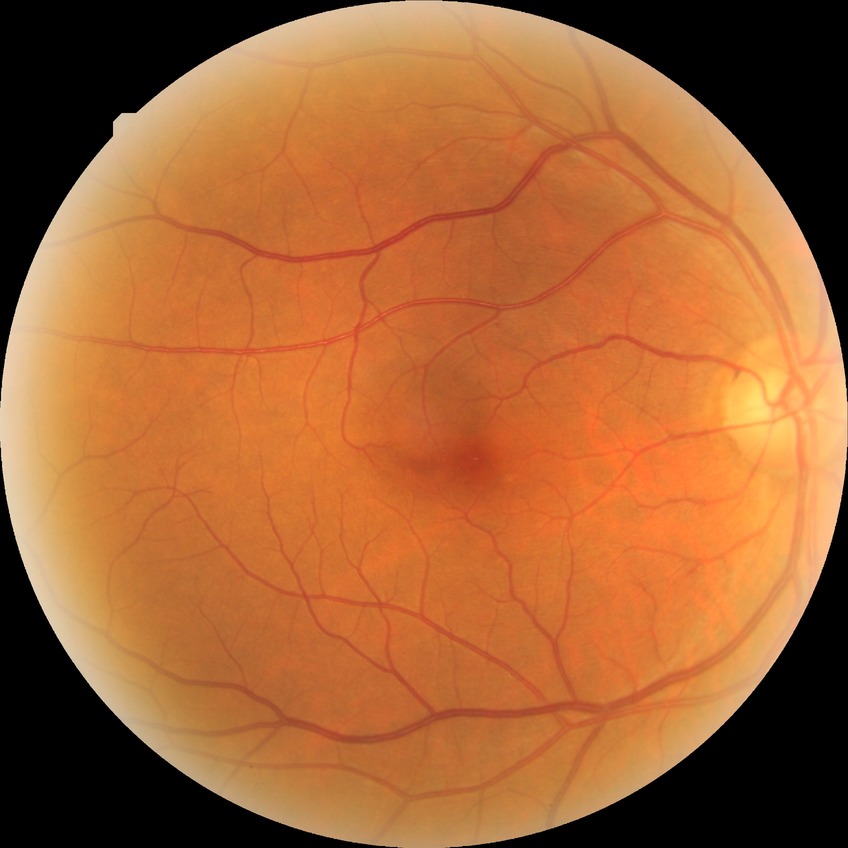 {"davis_grade": "NDR"}